45° field of view
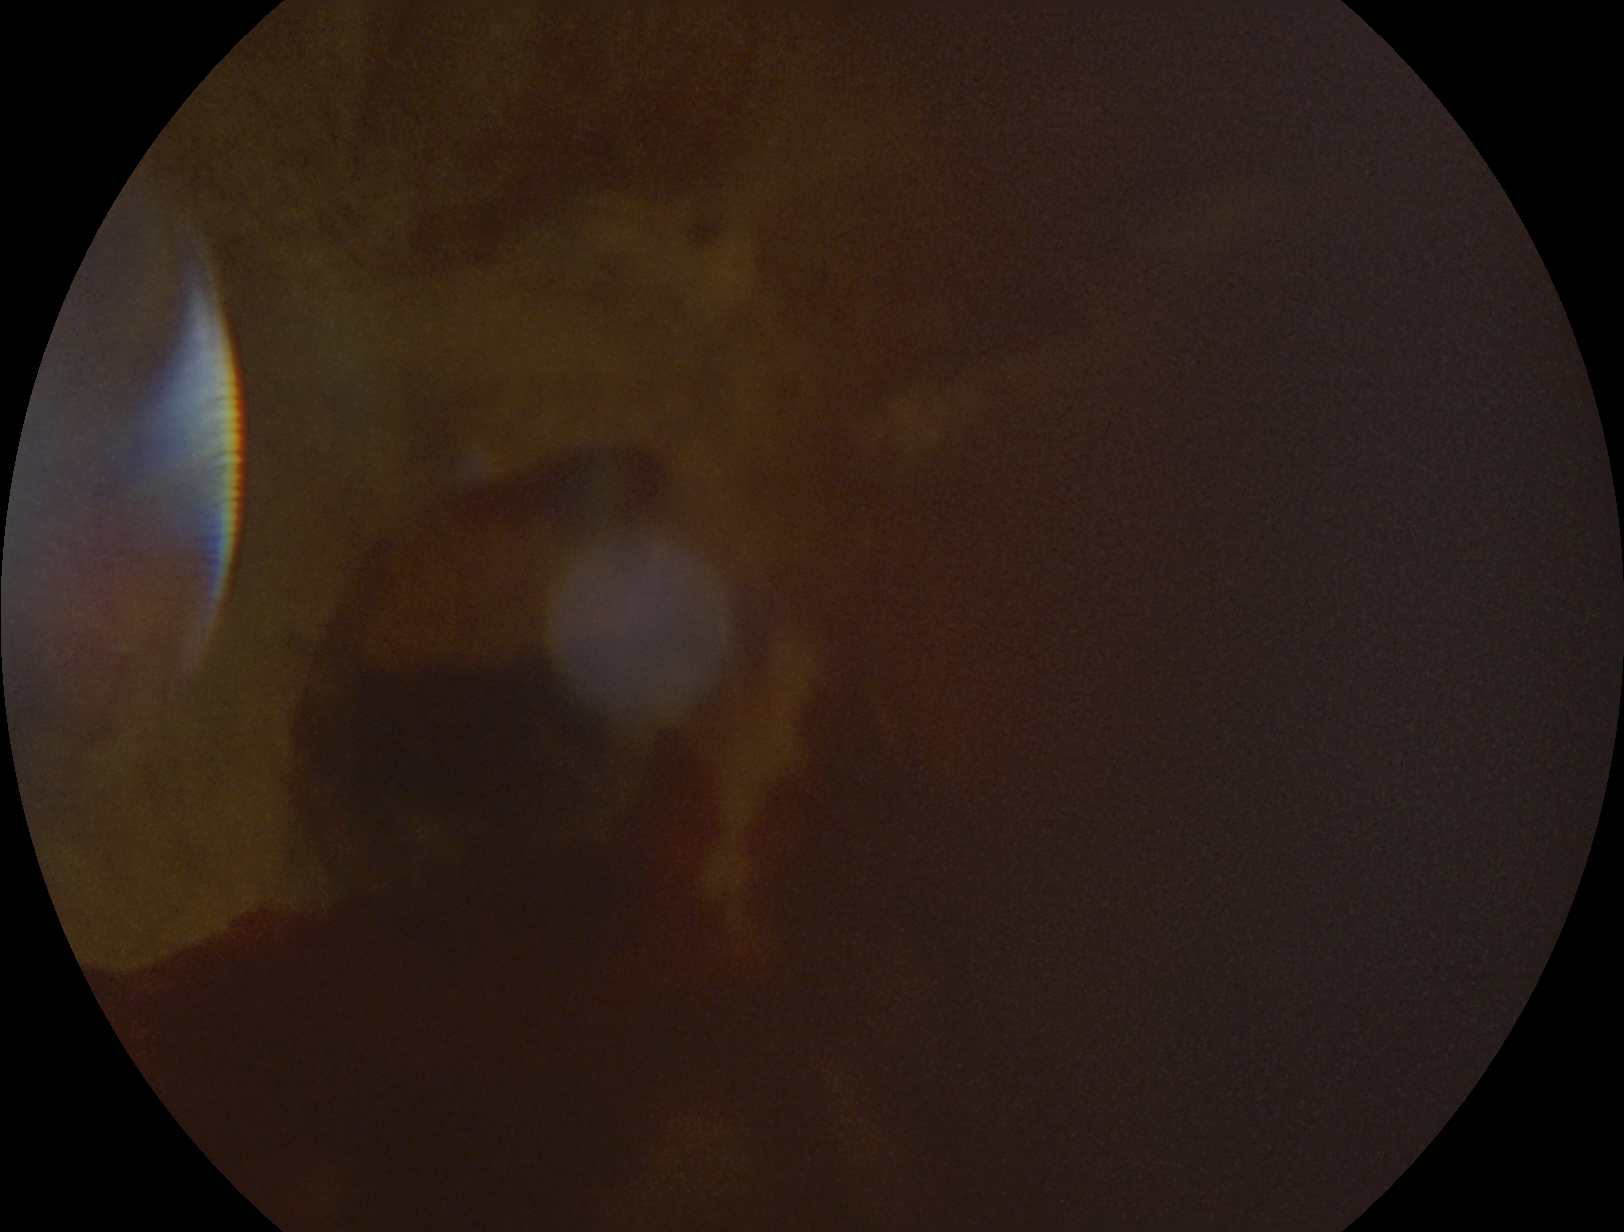

diabetic retinopathy grade: 4 (PDR); DR class: proliferative diabetic retinopathy.